Modified Davis classification
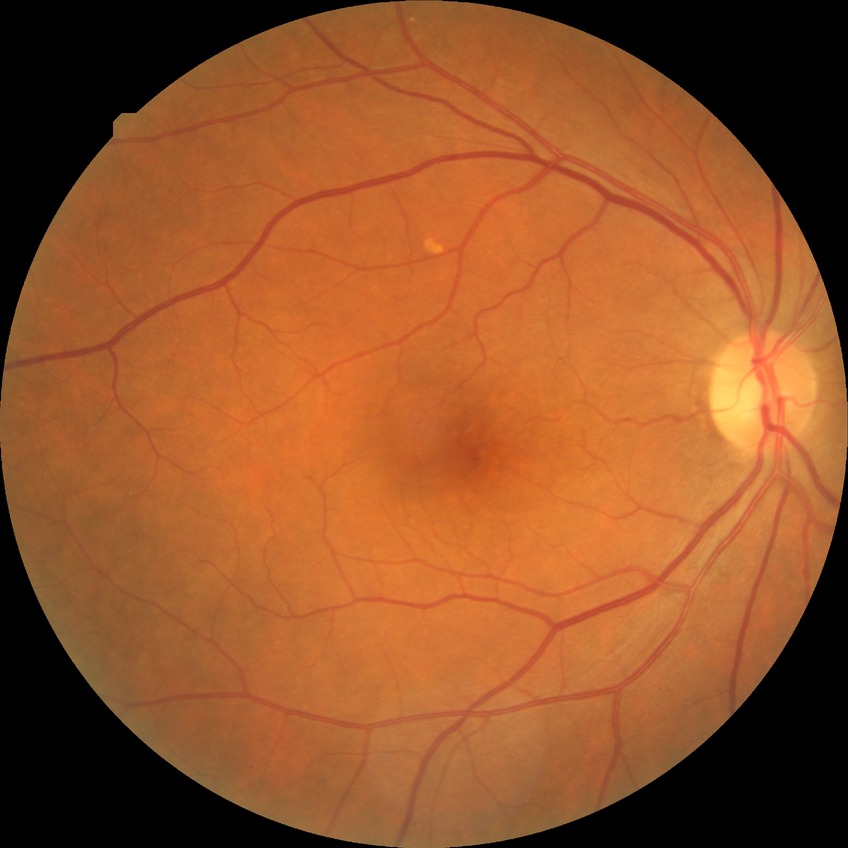 Diabetic retinopathy (DR) is no diabetic retinopathy (NDR).